Fundus photo
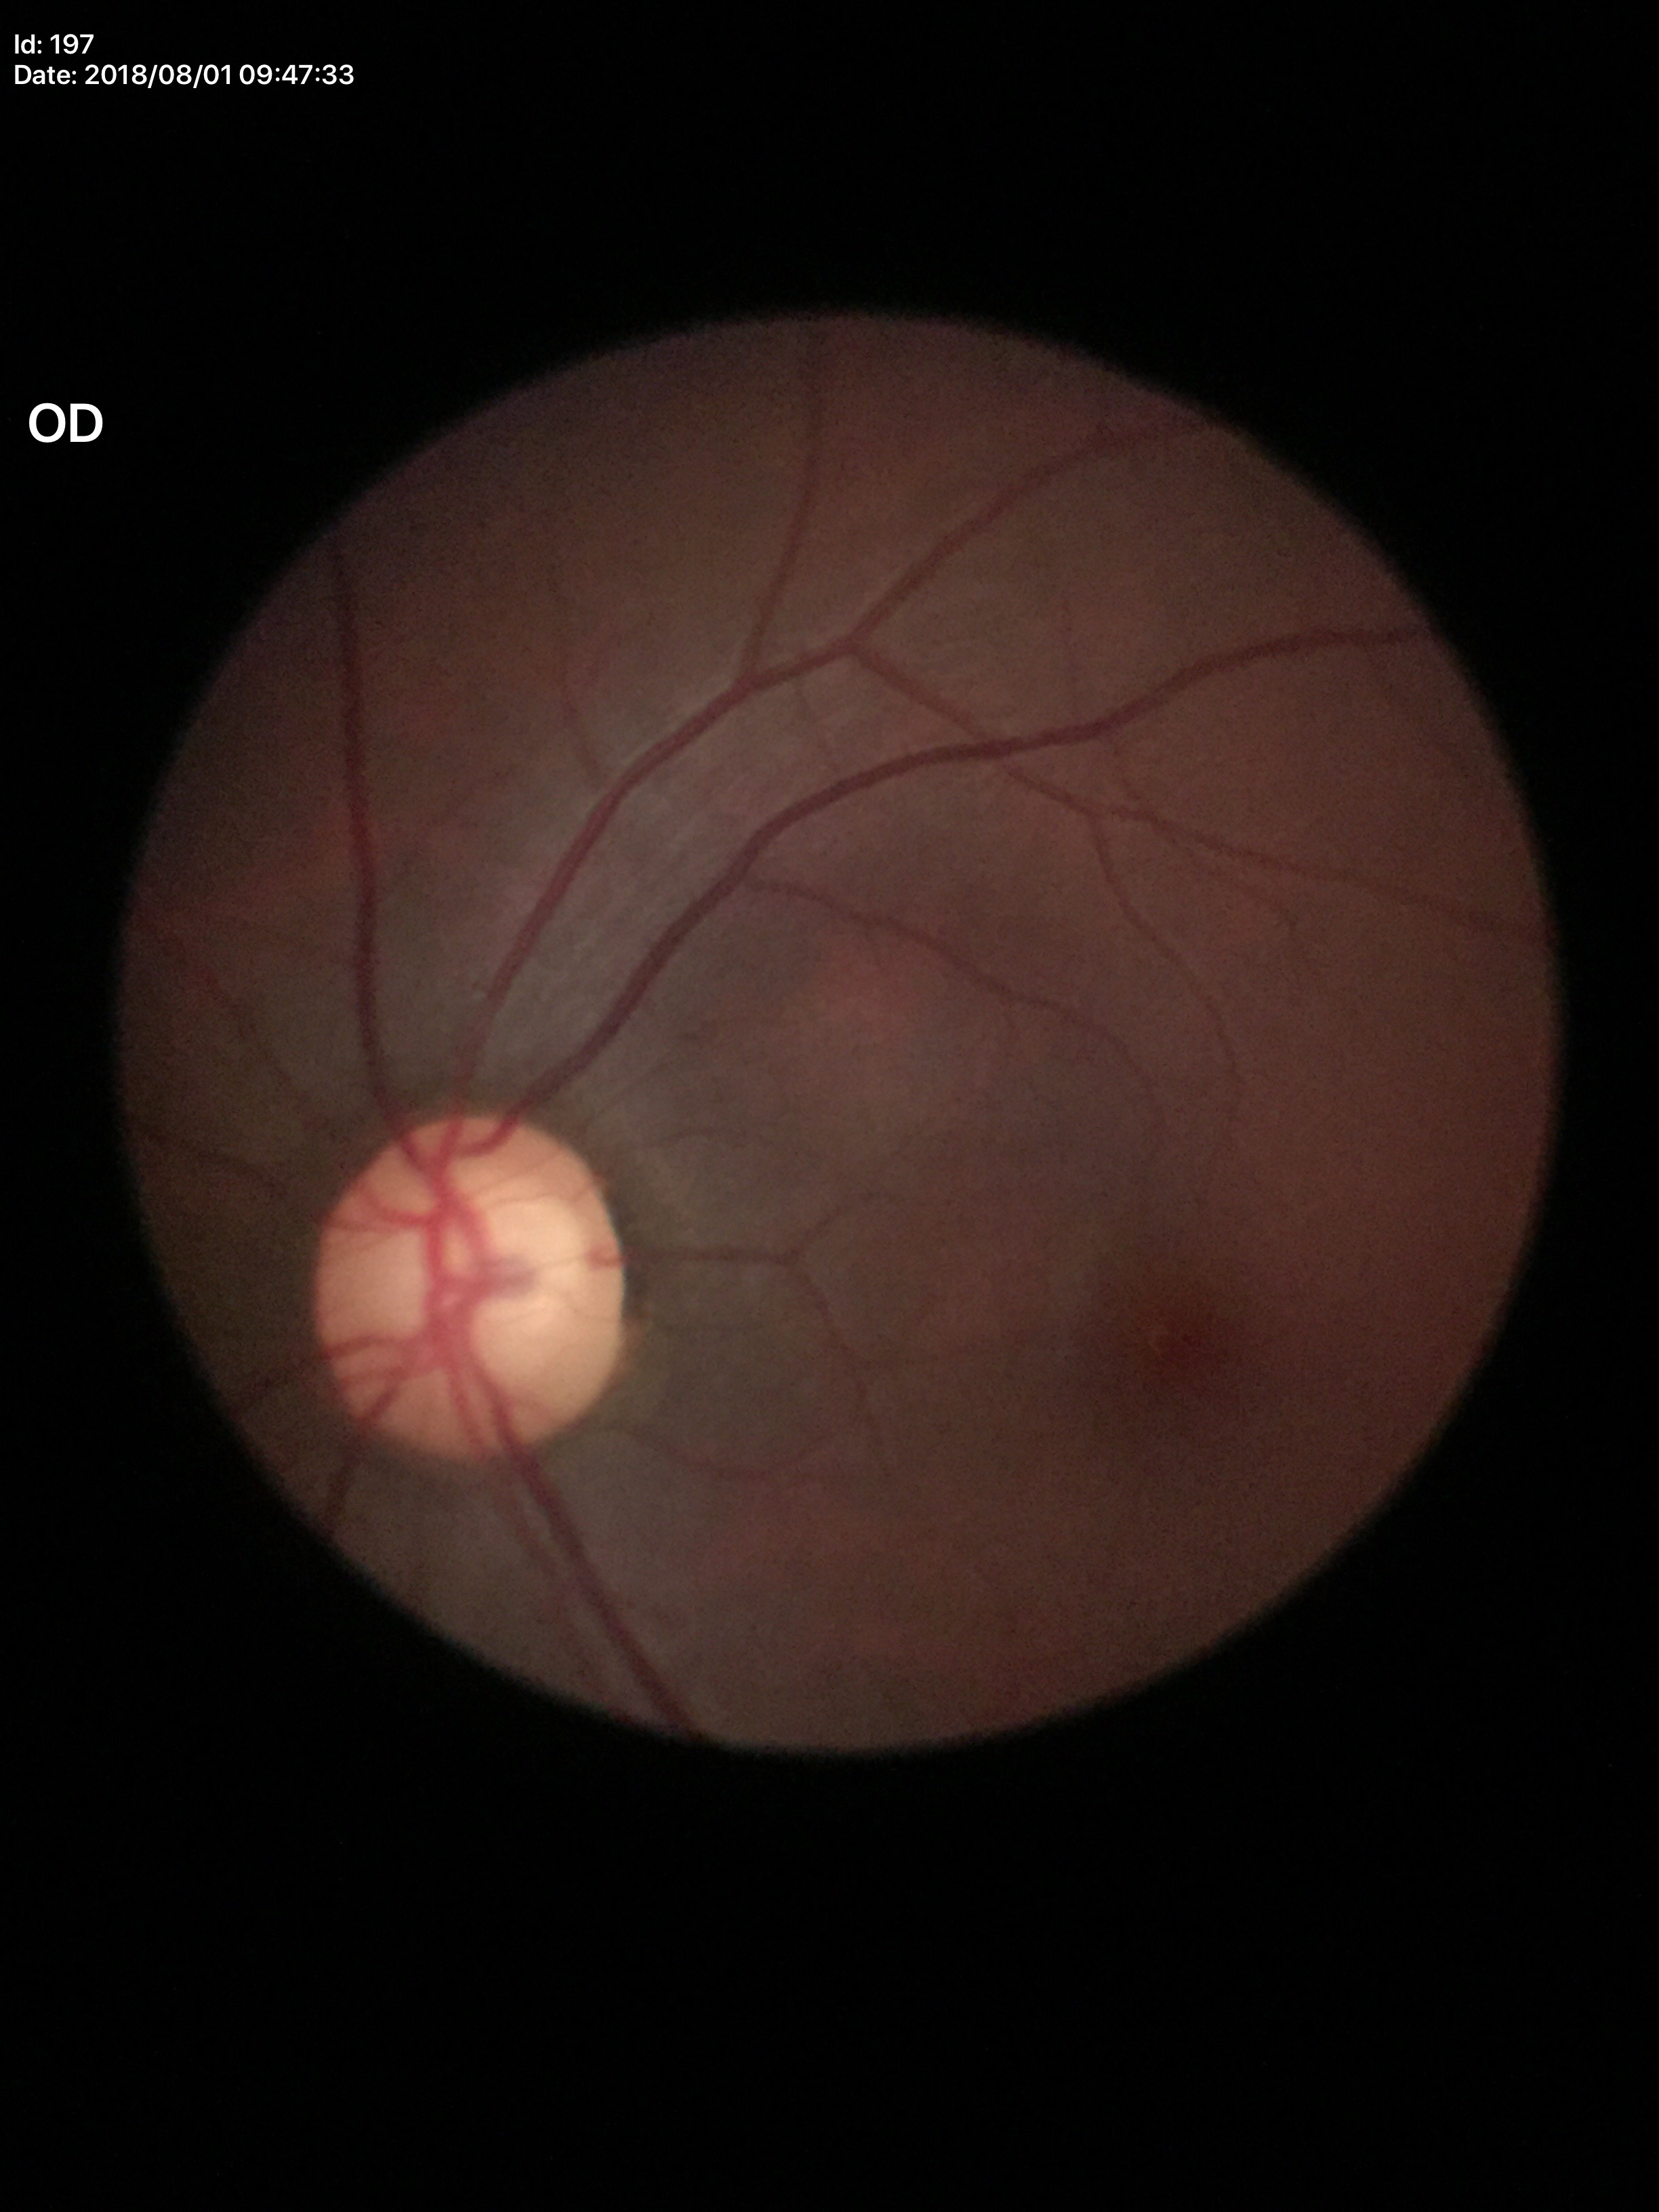
Glaucoma assessment: suspect | ACDR: 0.43 | HCDR: 0.66 | VCDR: 0.66.